Nonmydriatic fundus photograph · modified Davis grading:
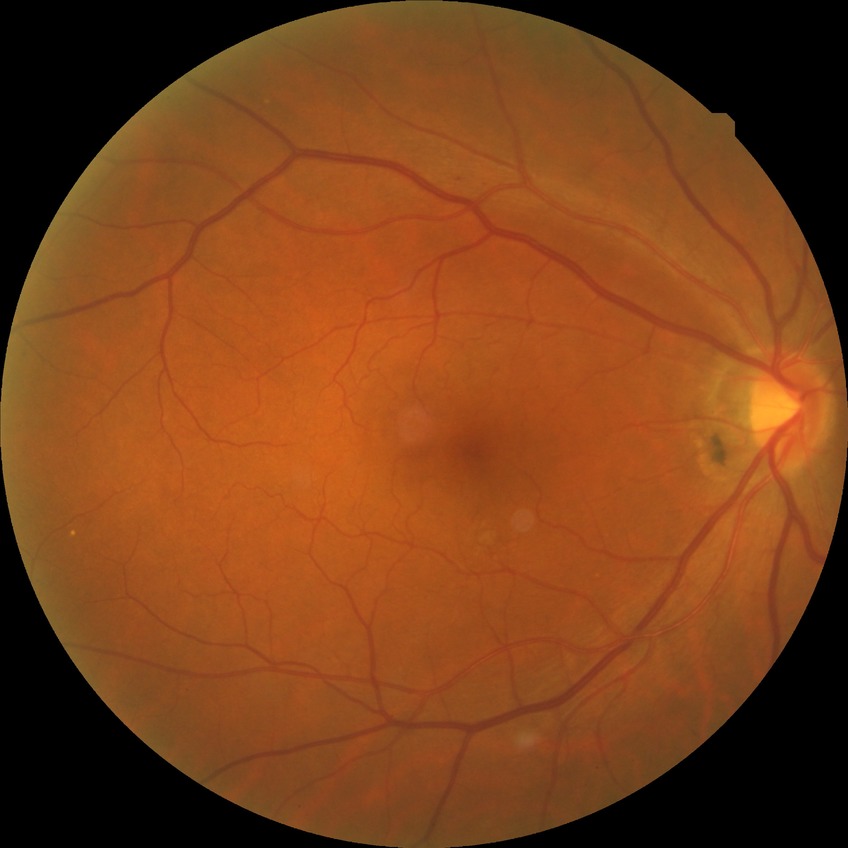

Assessment:
* DR class — non-proliferative diabetic retinopathy
* diabetic retinopathy (DR) — SDR (simple diabetic retinopathy)